50° field of view
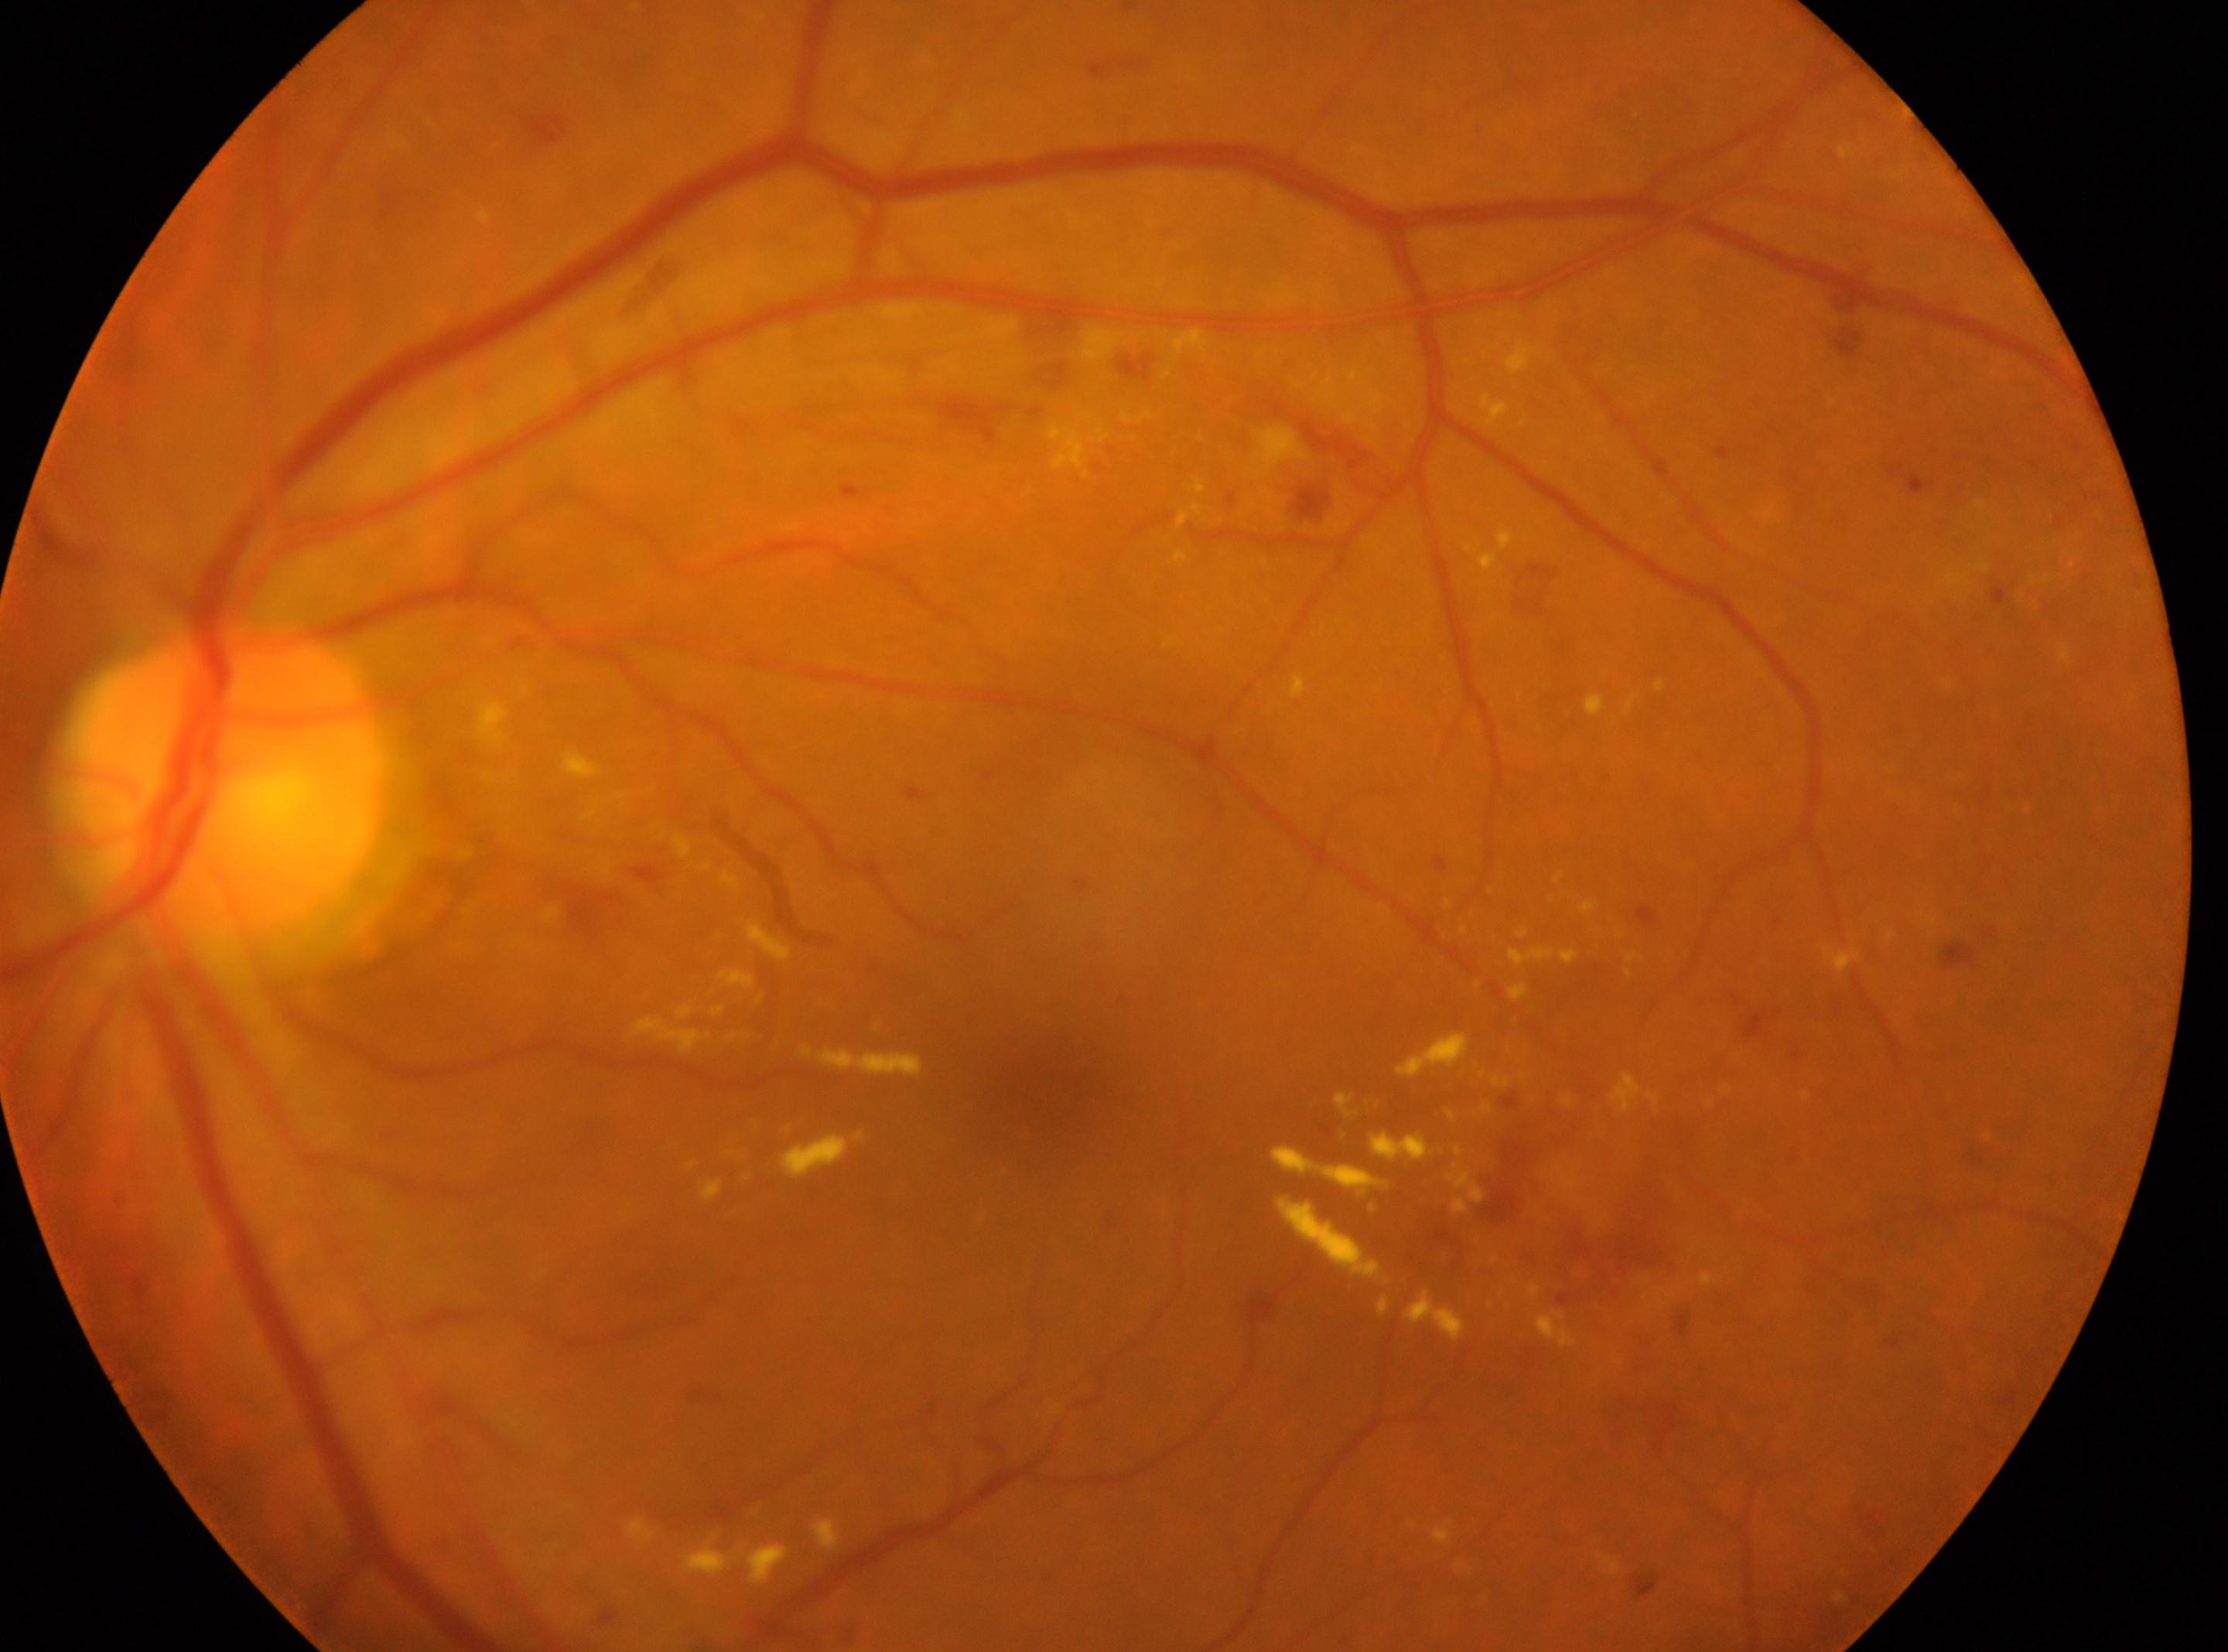

Disease class: non-proliferative diabetic retinopathy.
Eye: left eye.
Fovea located at (1049, 1089).
Optic disc center located at (231, 782).
DR stage is grade 3 (severe NPDR) — more than 20 intraretinal hemorrhages in each of 4 quadrants, definite venous beading in 2 or more quadrants, or prominent intraretinal microvascular abnormalities in 1 or more quadrants, with no signs of proliferative retinopathy.